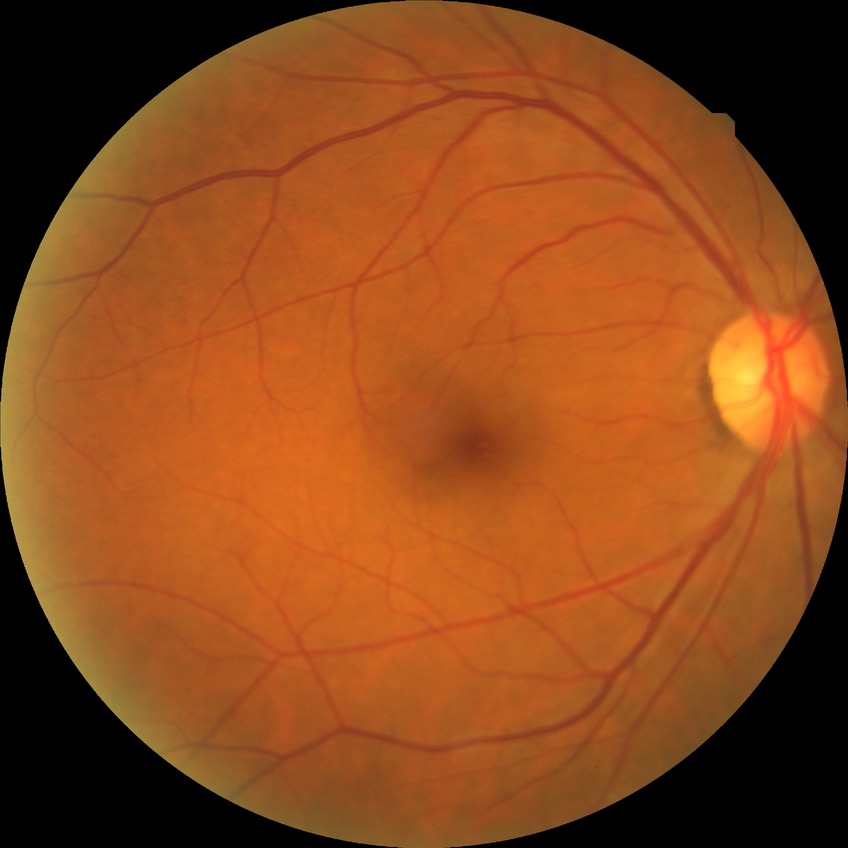

Assessment:
– DR severity: NDR